Davis DR grading, FOV: 45 degrees
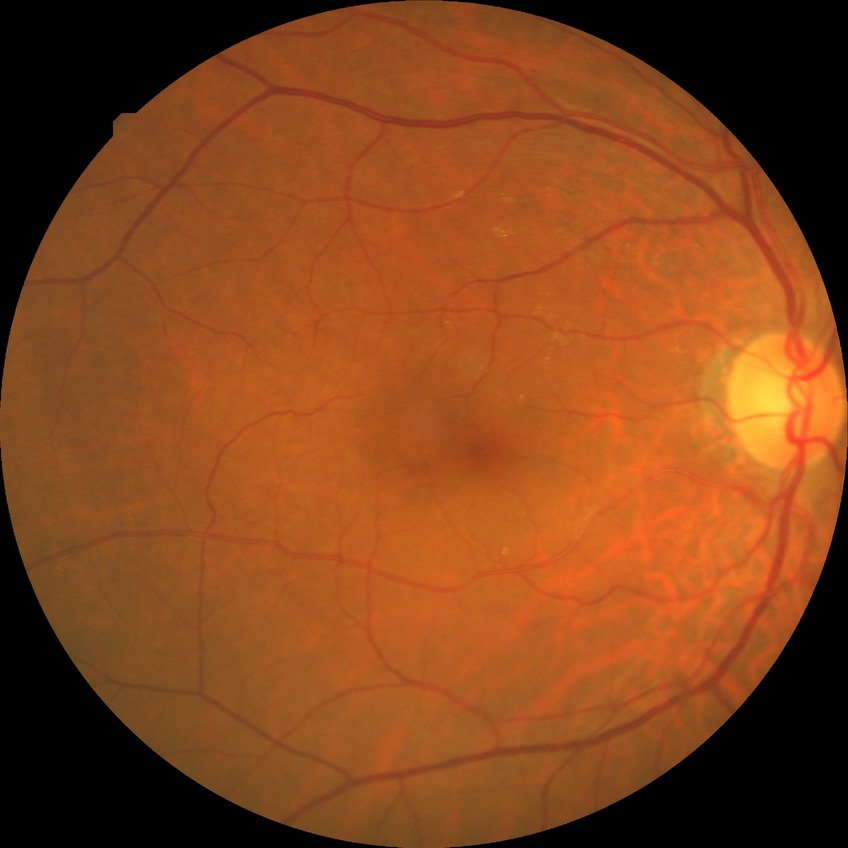
modified Davis grade@NDR.